30° field of view. Central corneal thickness 570 µm. 2212x1661px. Topcon TRC-NW400. Non-mydriatic acquisition. Centered on the optic disc. 48 years old. Color fundus image — 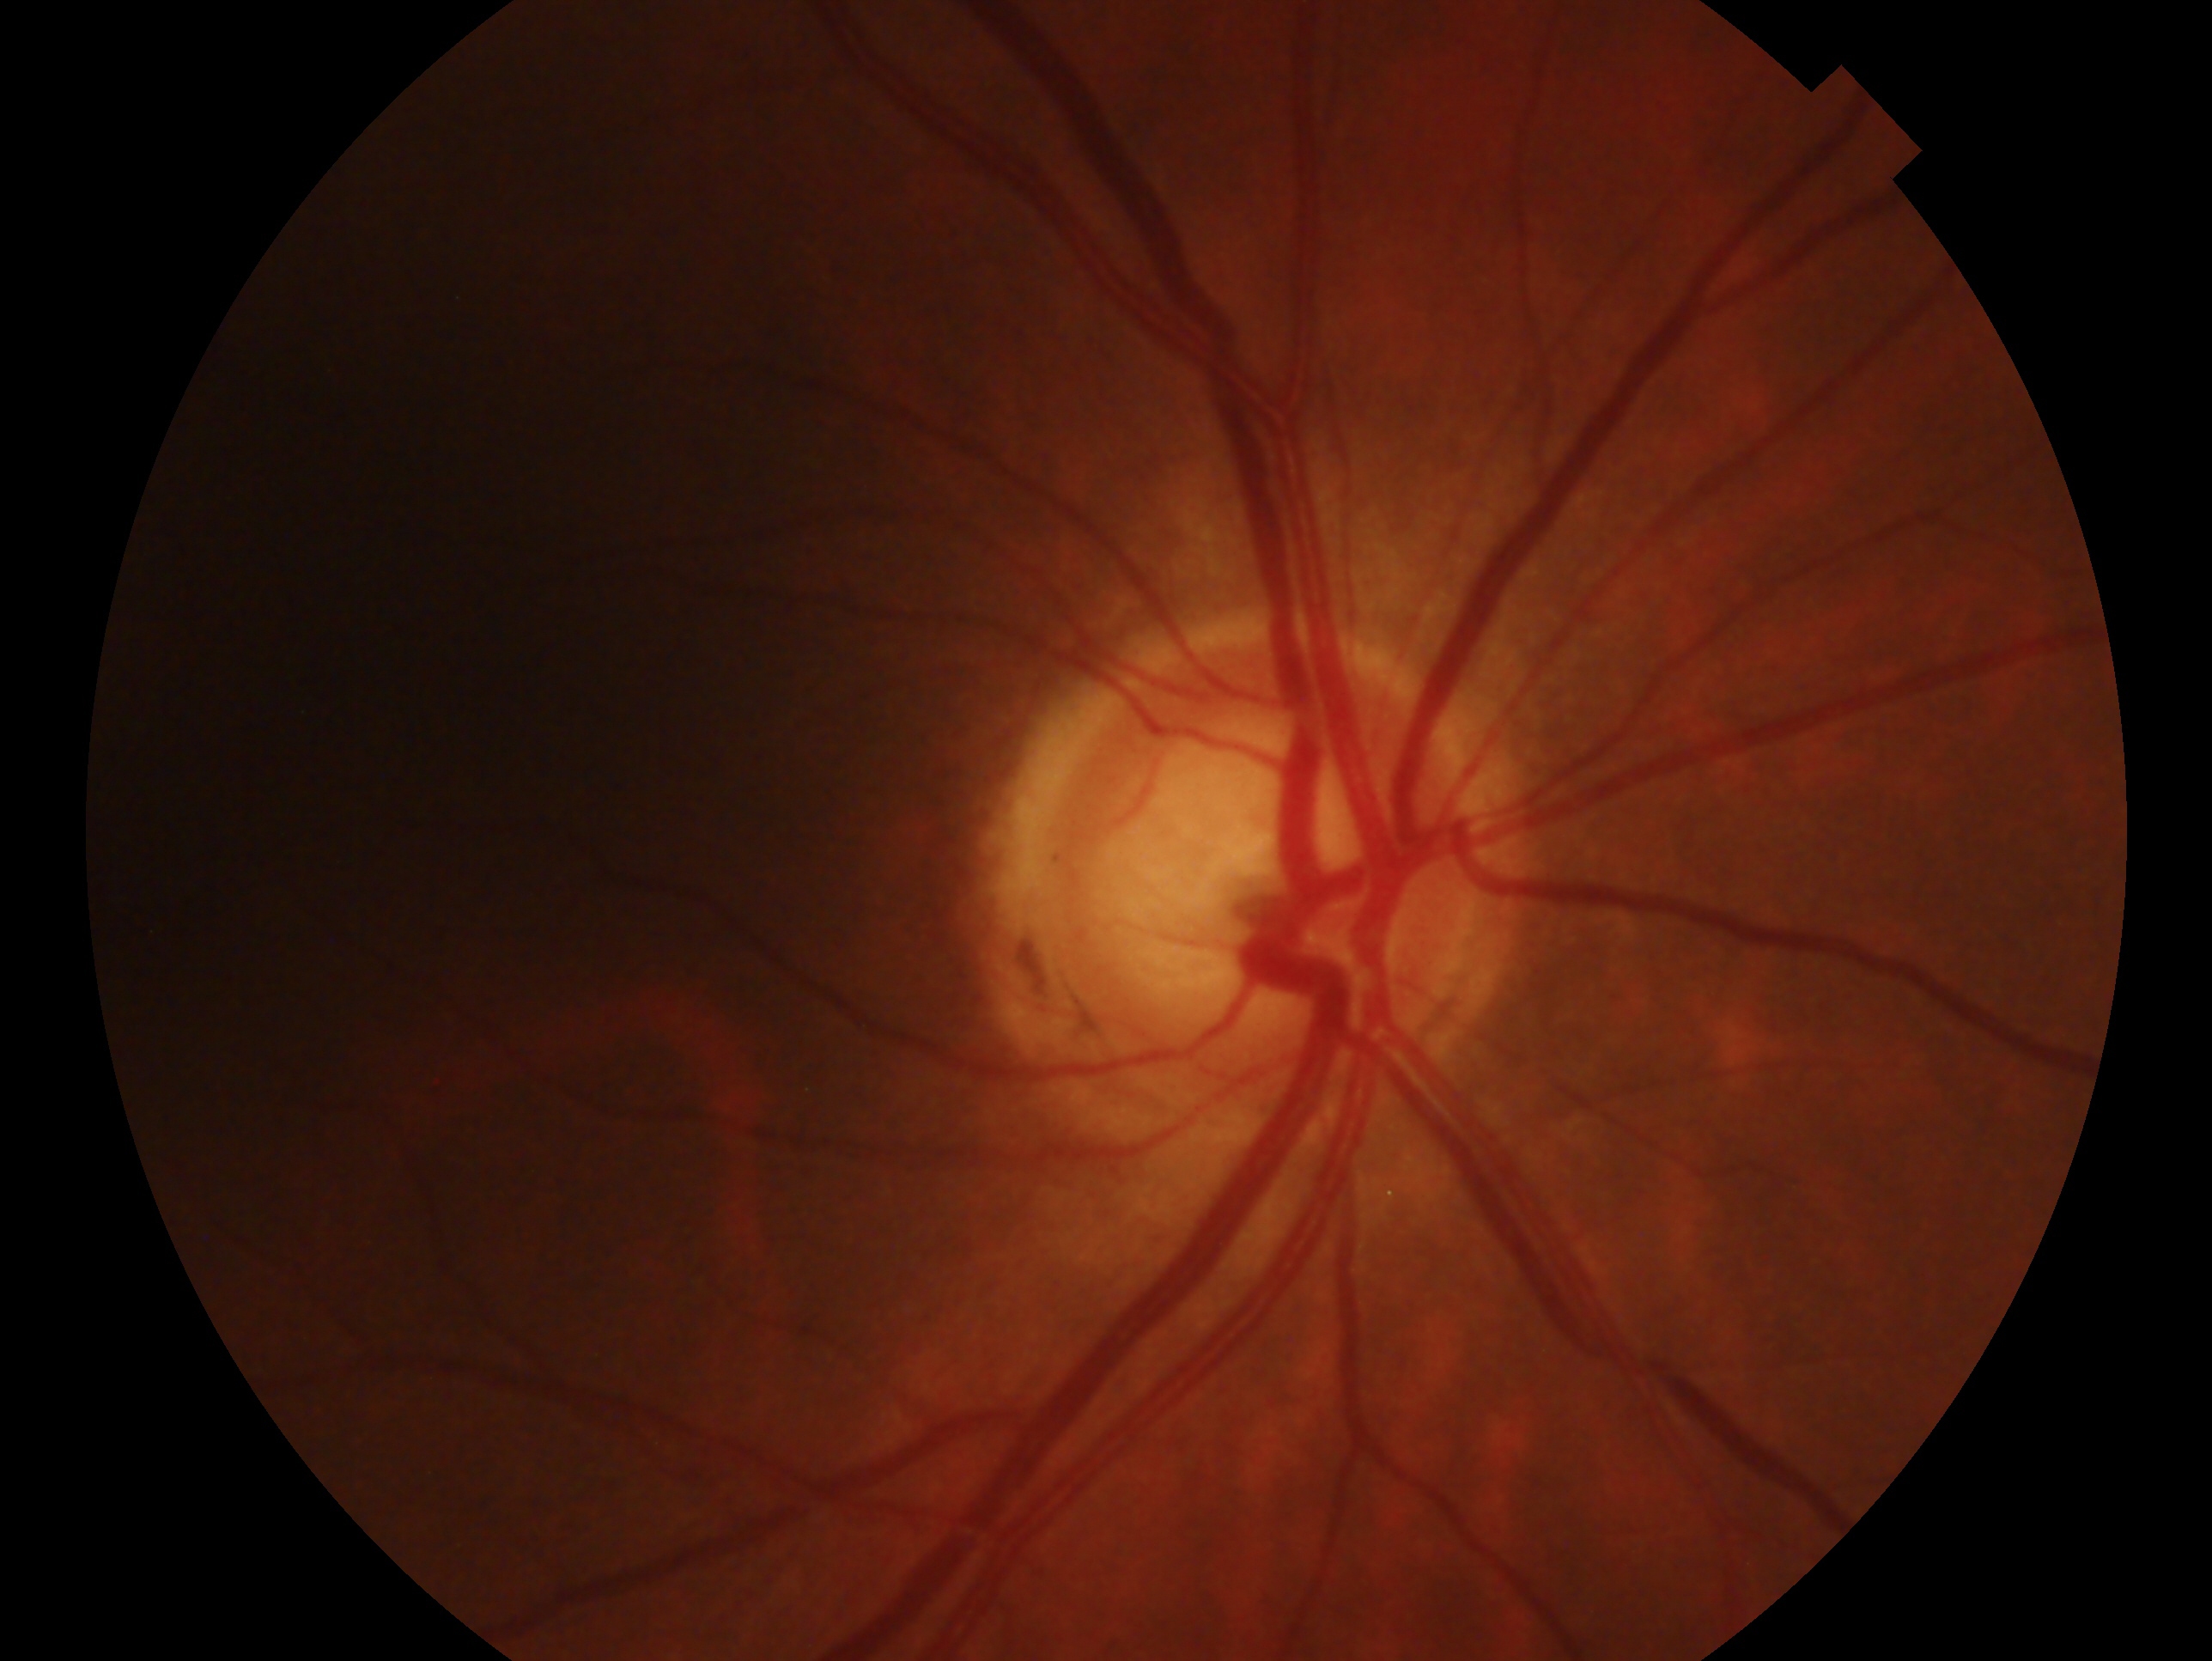
Impression — glaucoma cannot be excluded. The image shows the right eye.